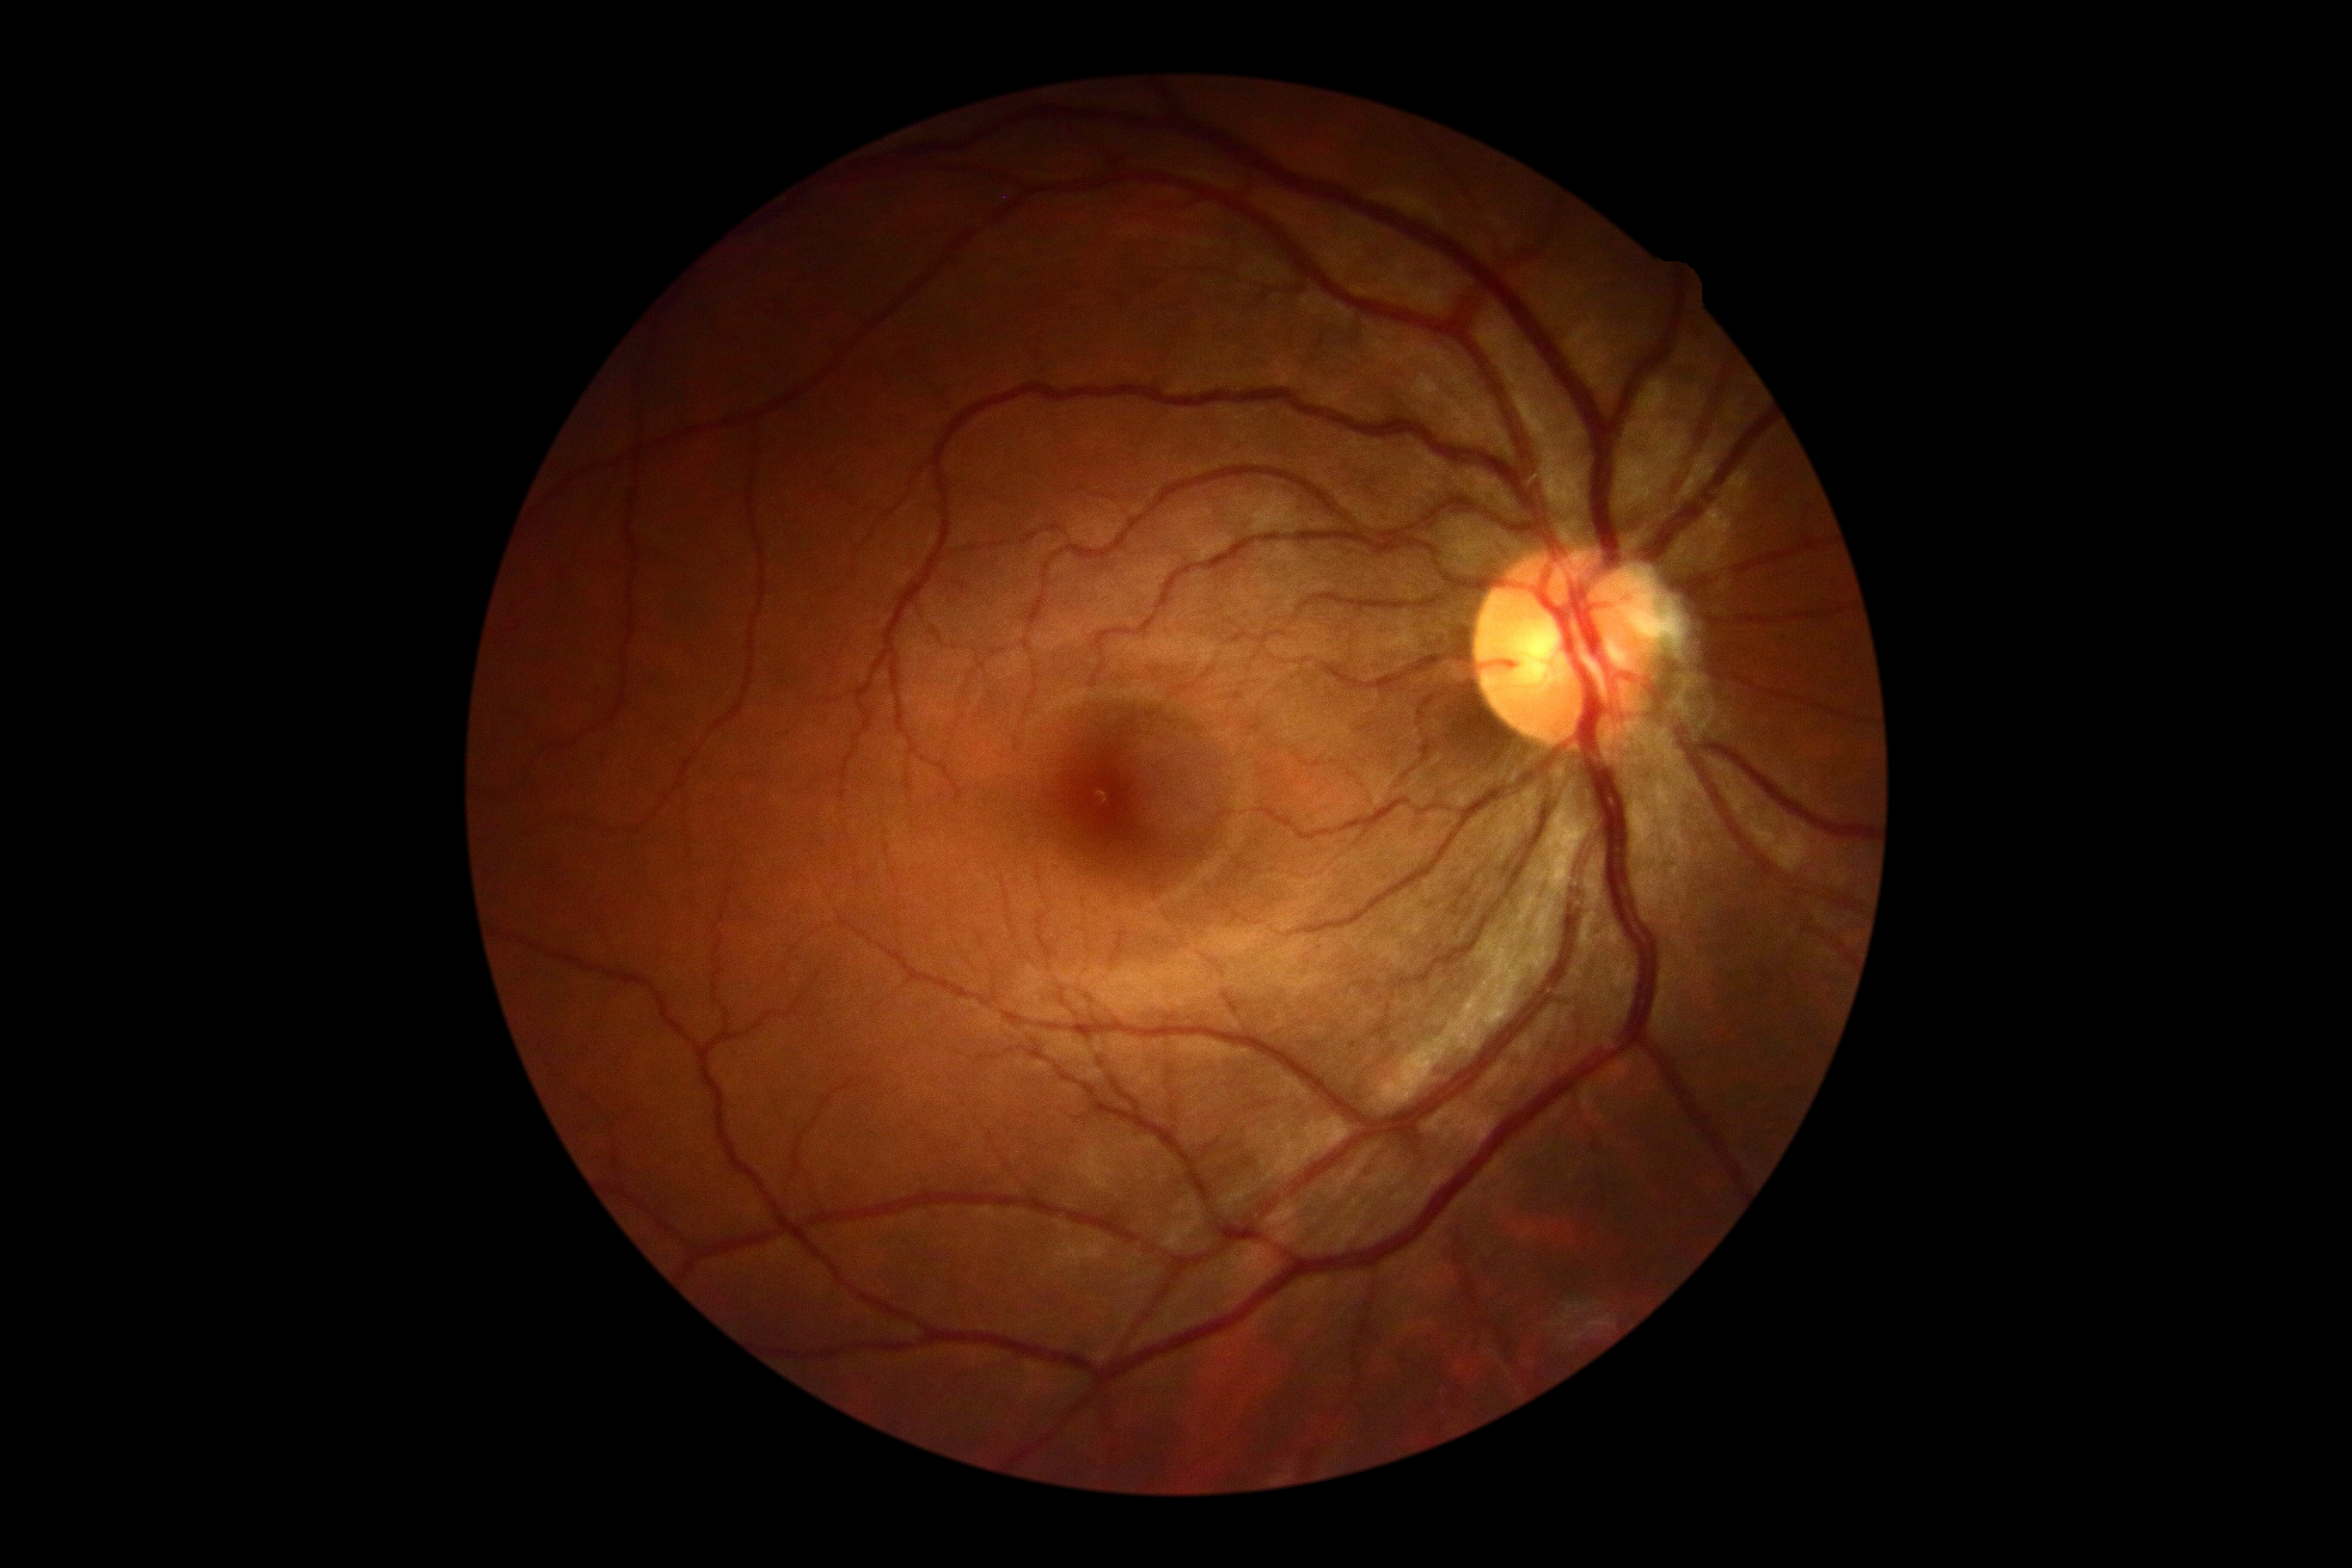
DR grade: 0/4; DR impression: no apparent DR.